1932x1932. Color fundus photograph:
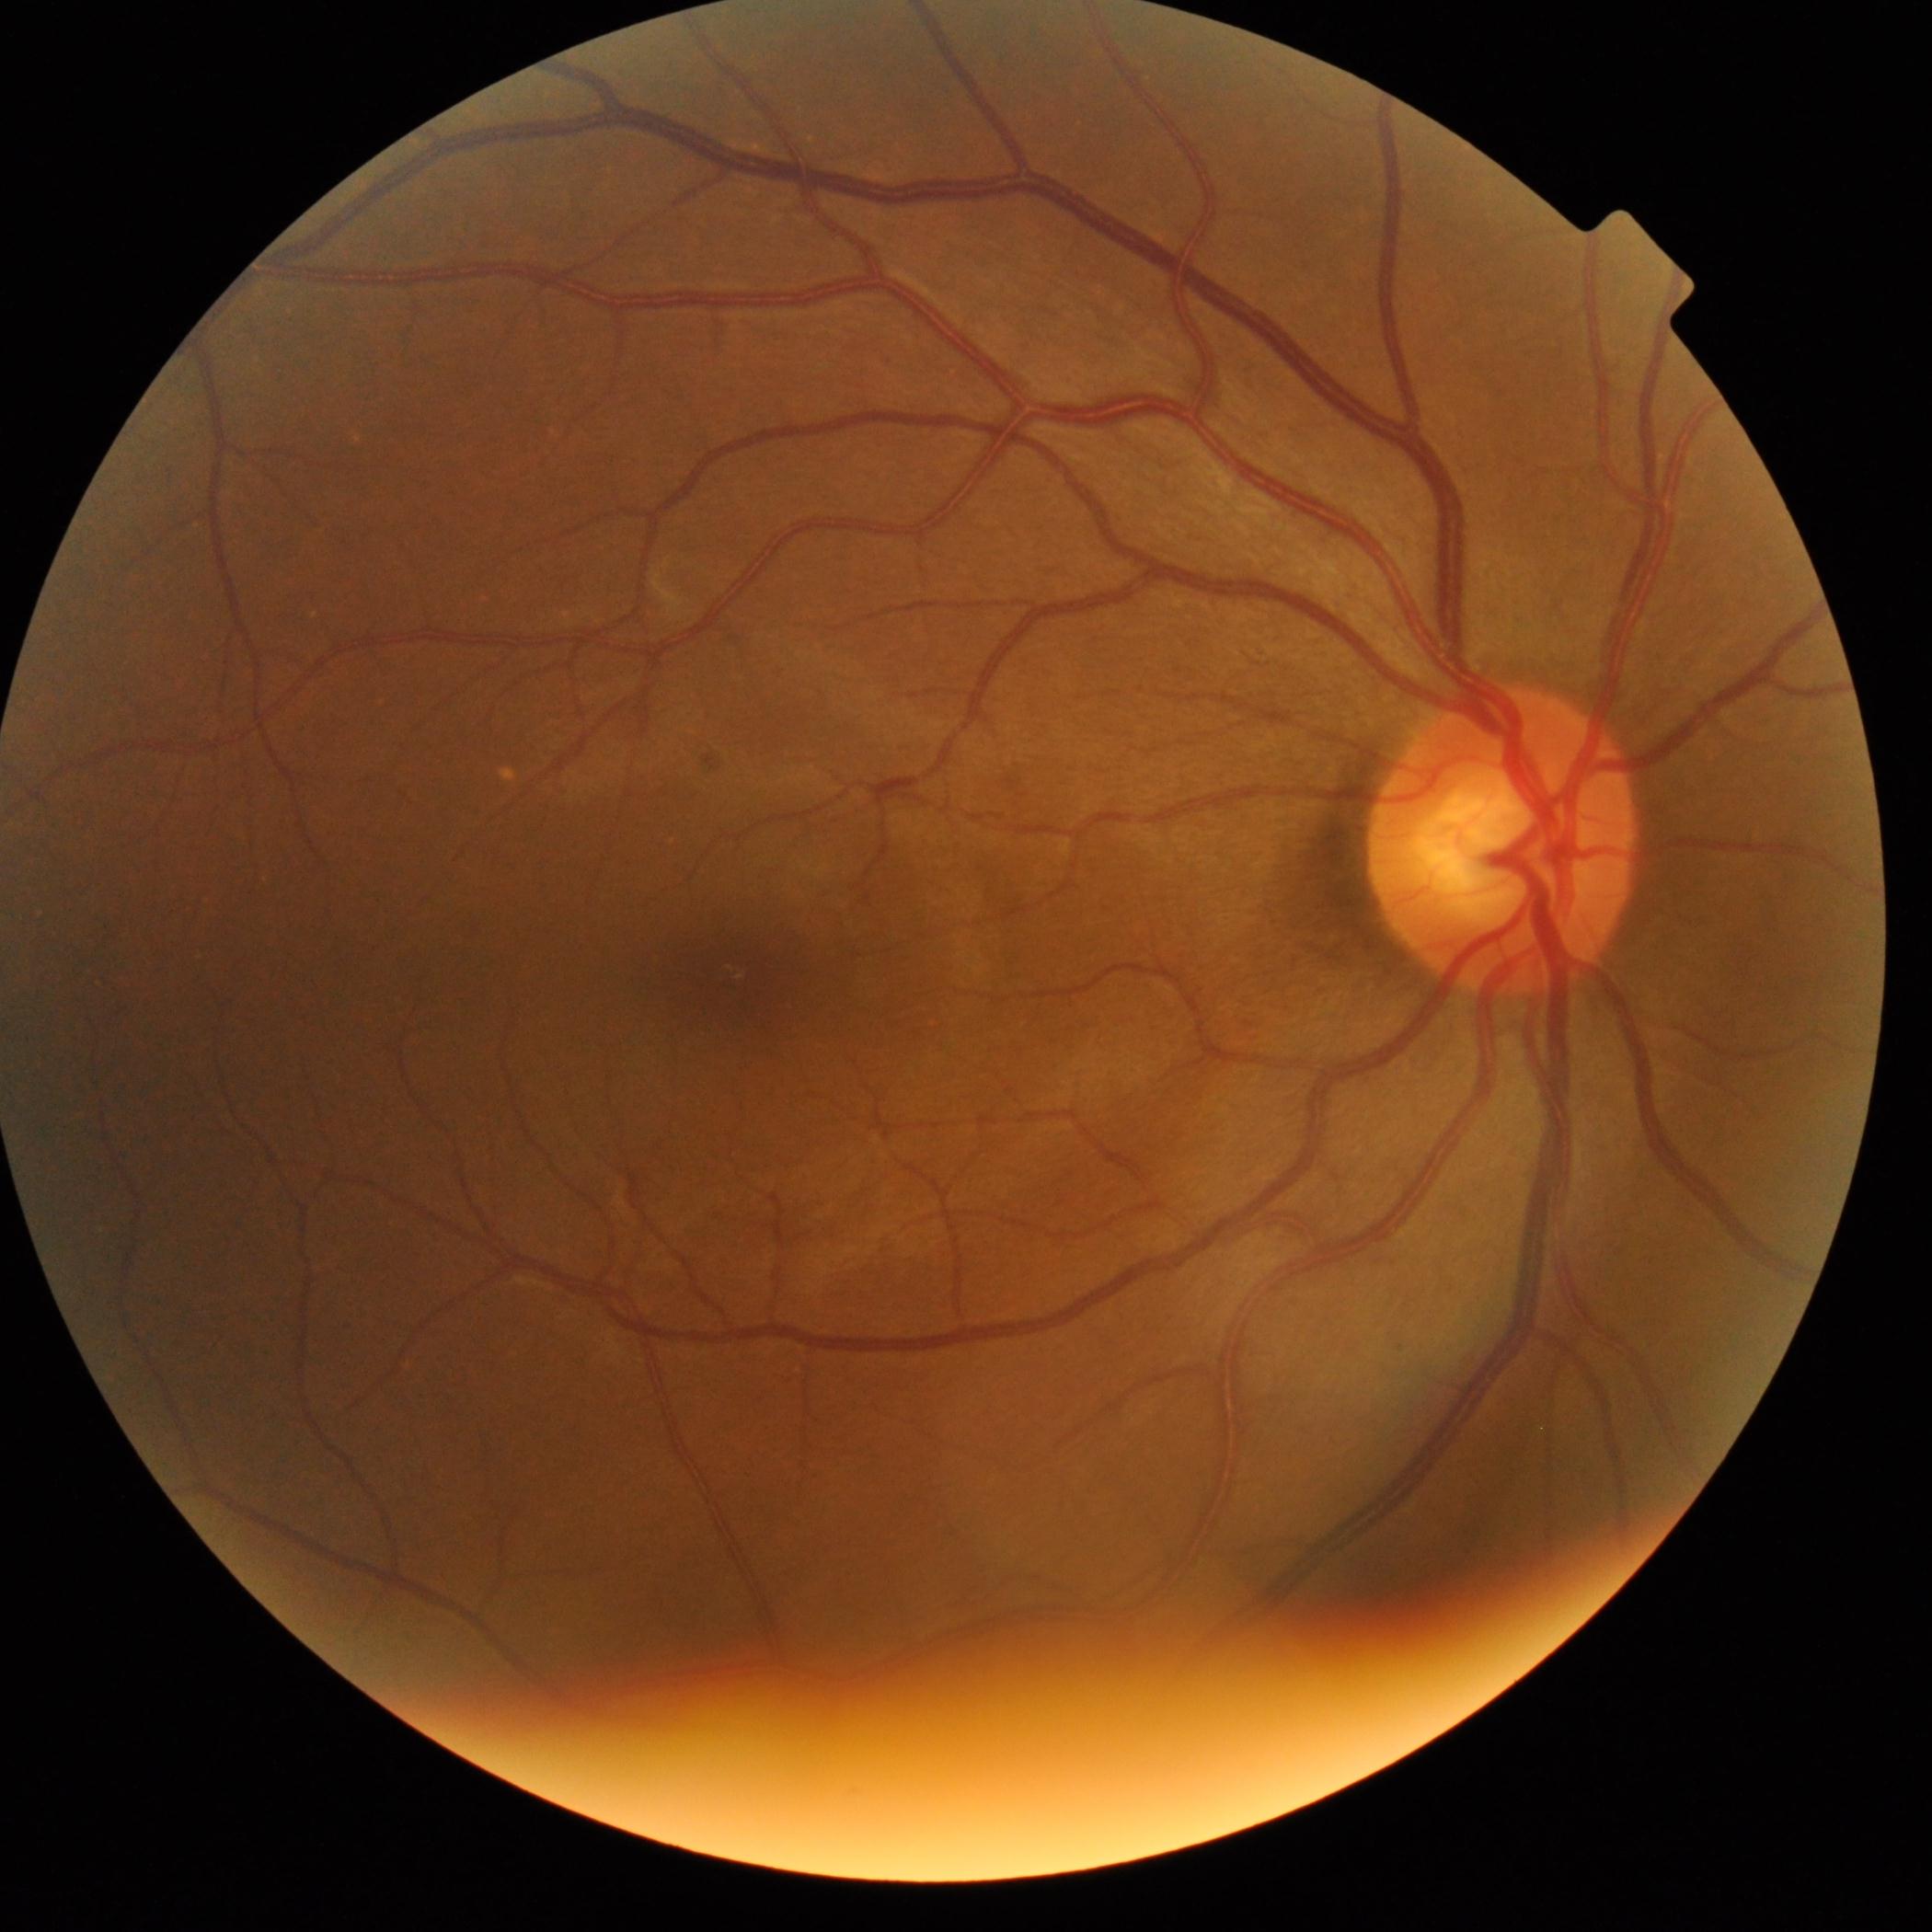

Diabetic retinopathy severity is no apparent diabetic retinopathy (grade 0).